Color fundus photograph — 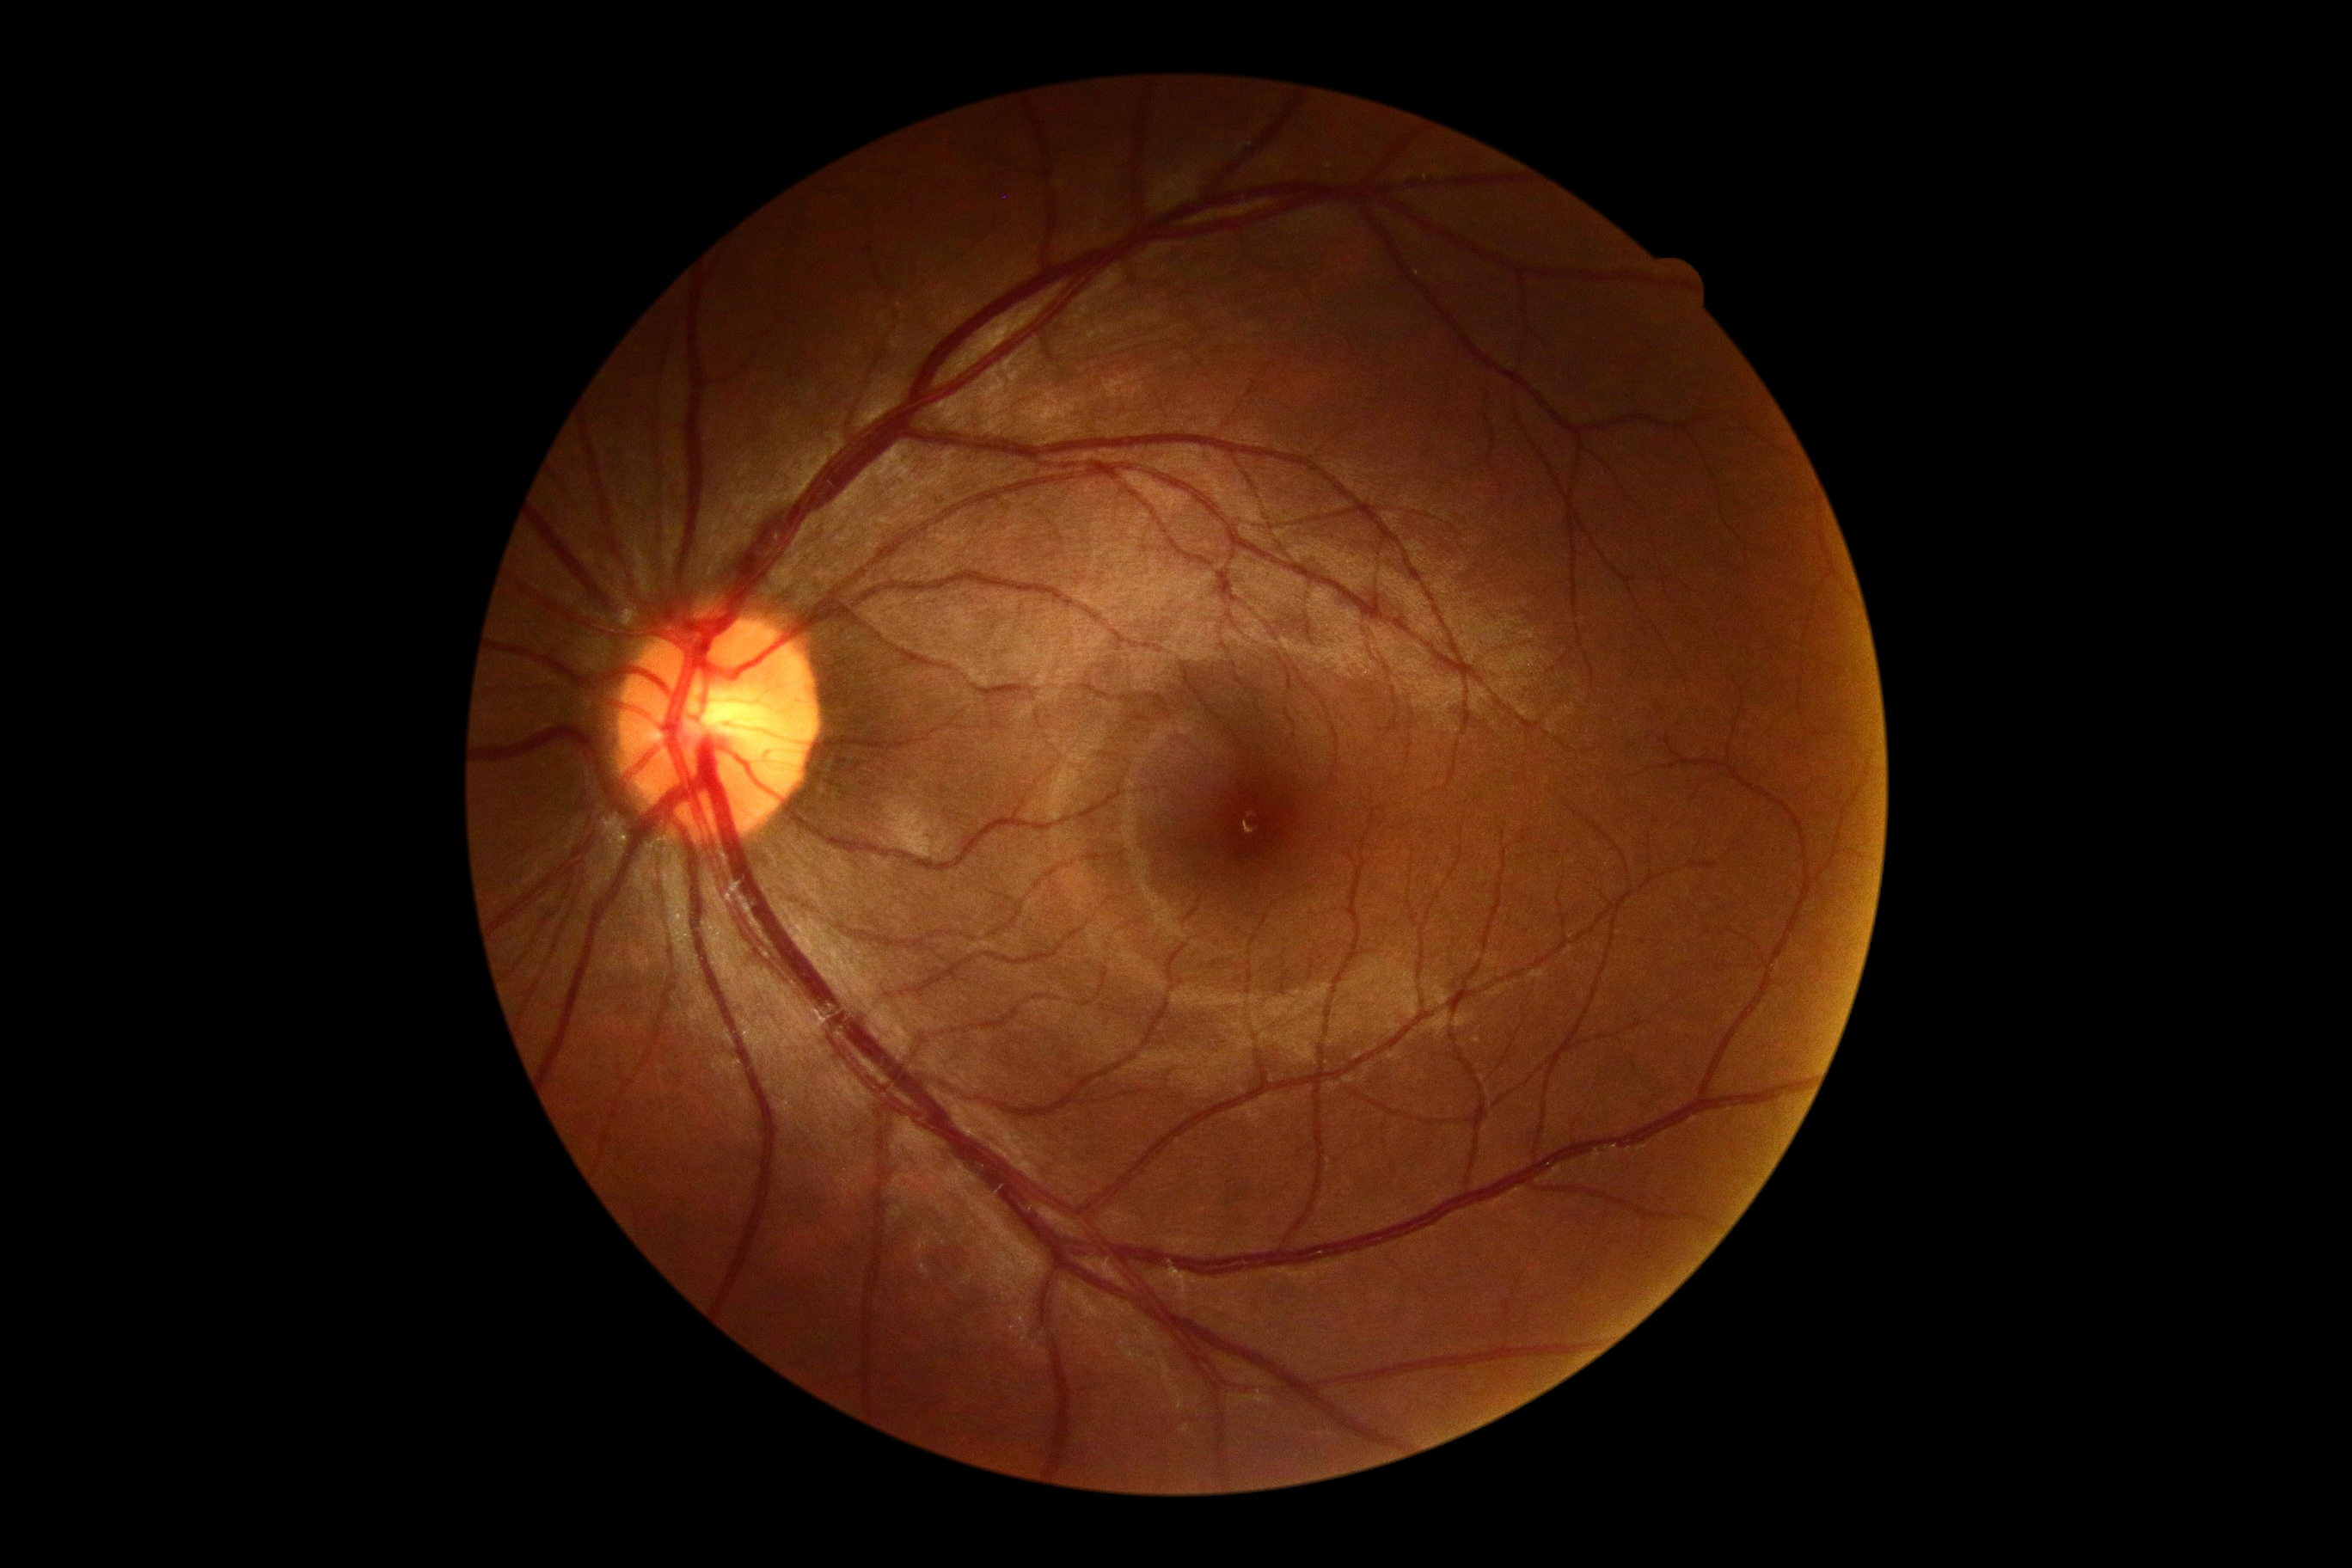 No diabetic retinal disease findings. Retinopathy grade is no apparent diabetic retinopathy (0).